Wide-field fundus photograph of an infant — 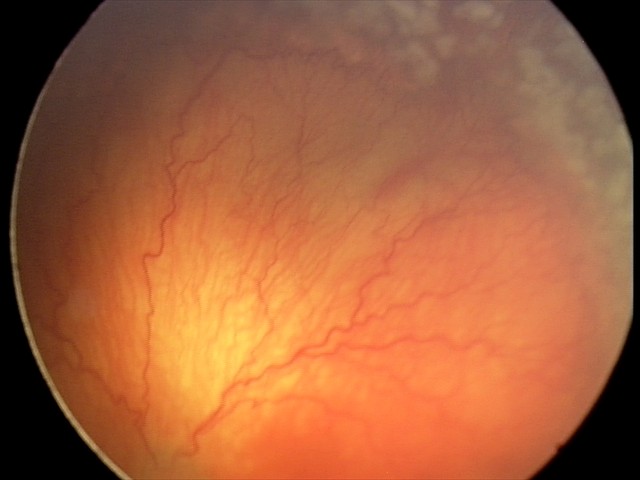
Plus disease present.
Series diagnosed as aggressive retinopathy of prematurity.